45-degree field of view.
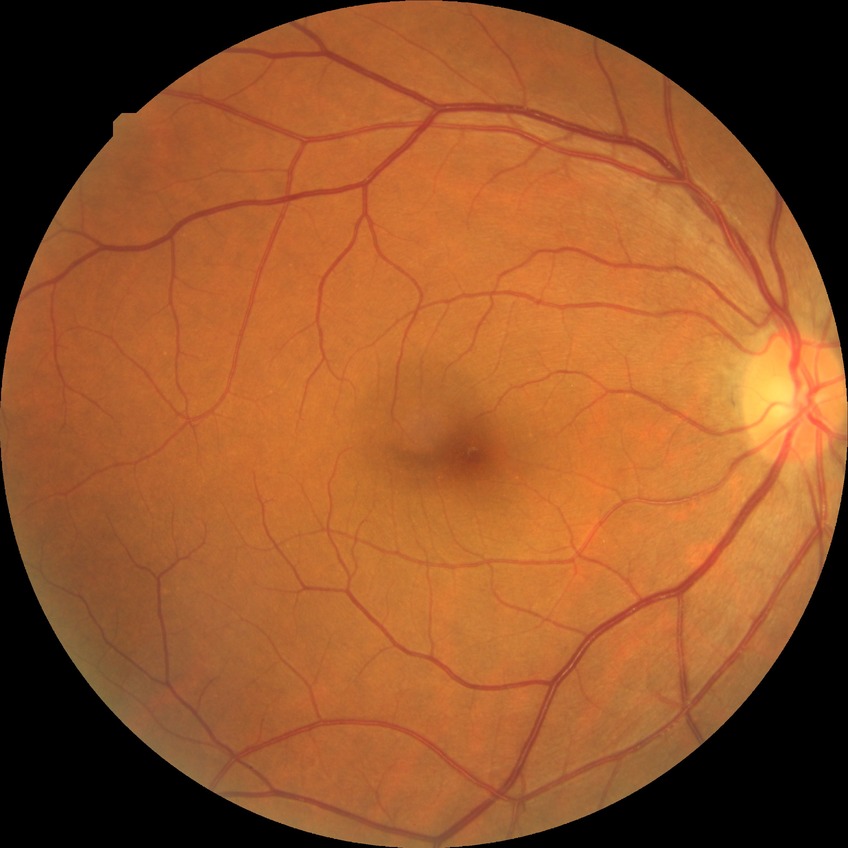

Assessment:
– retinopathy grade: no diabetic retinopathy